45° FOV, color fundus photograph.
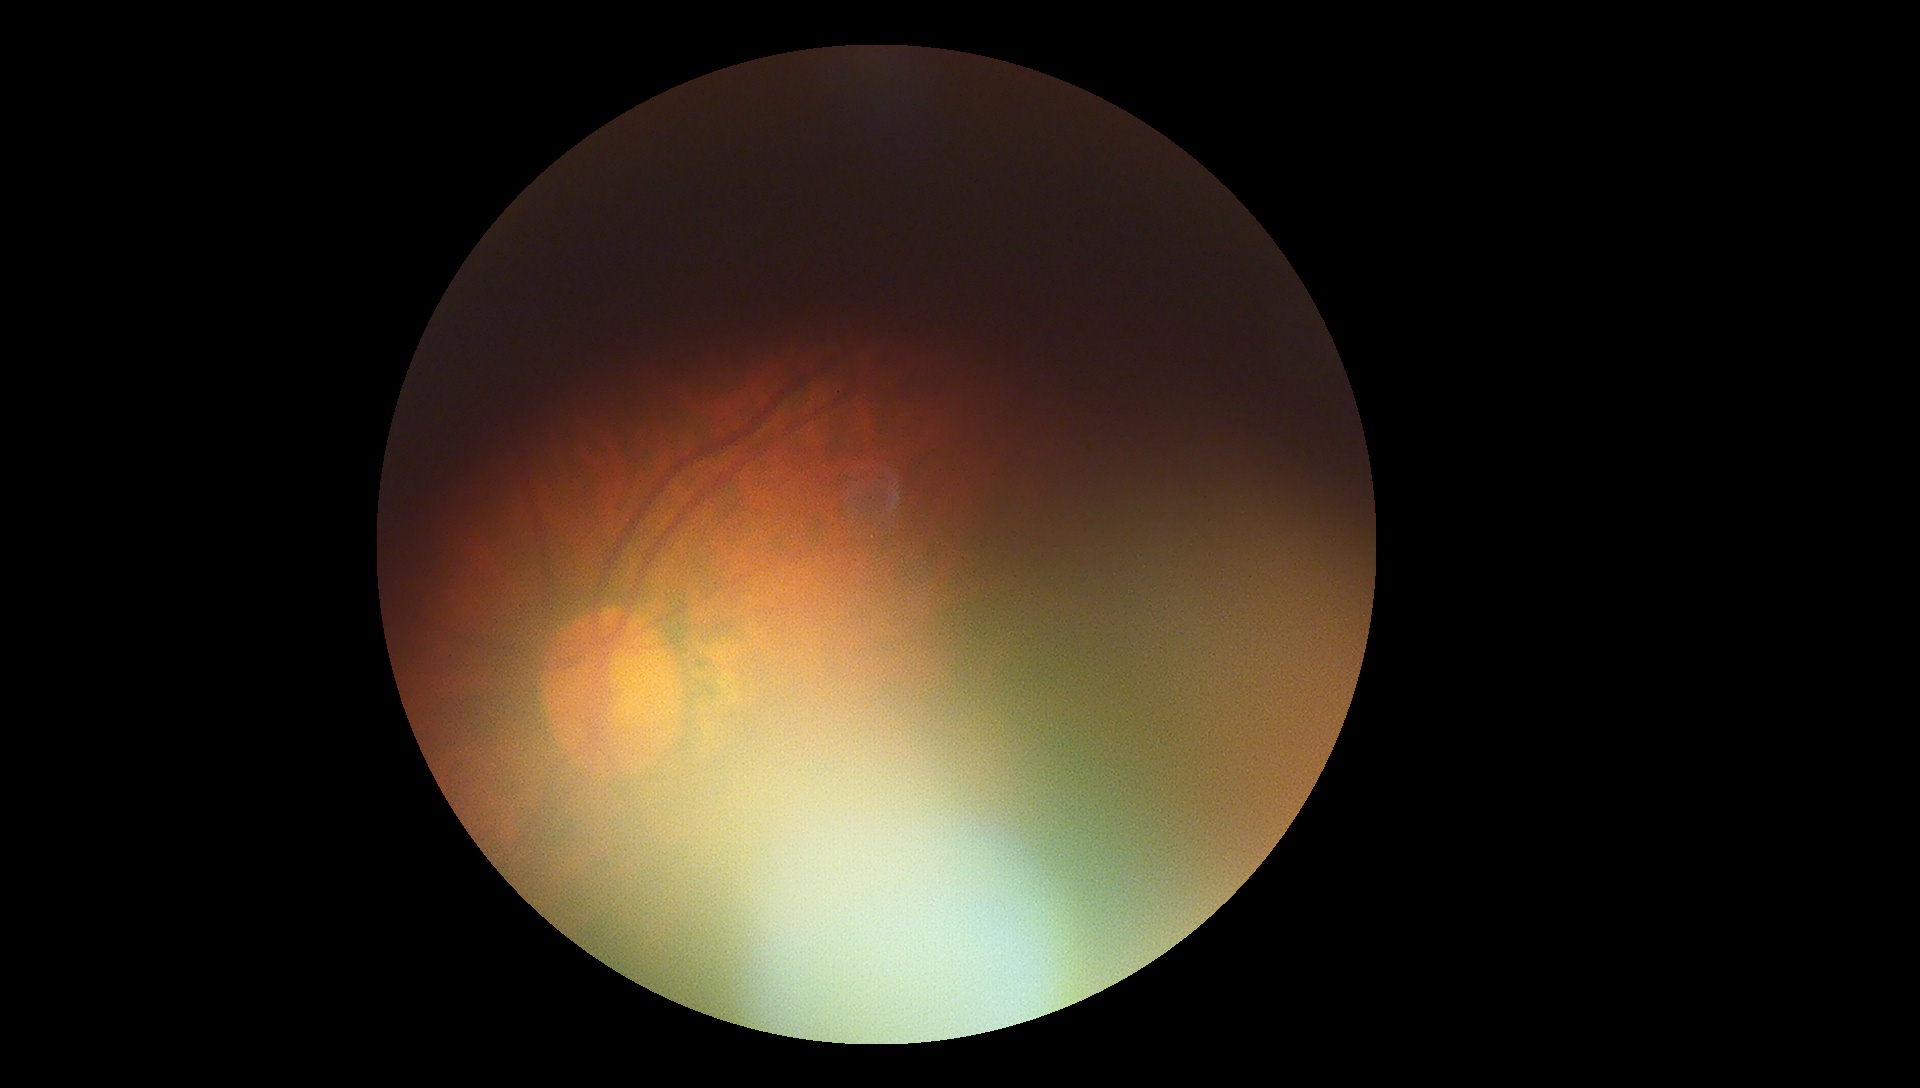 Retinopathy grade: ungradable.